FOV: 45 degrees; CFP; image size 1960x1897 — 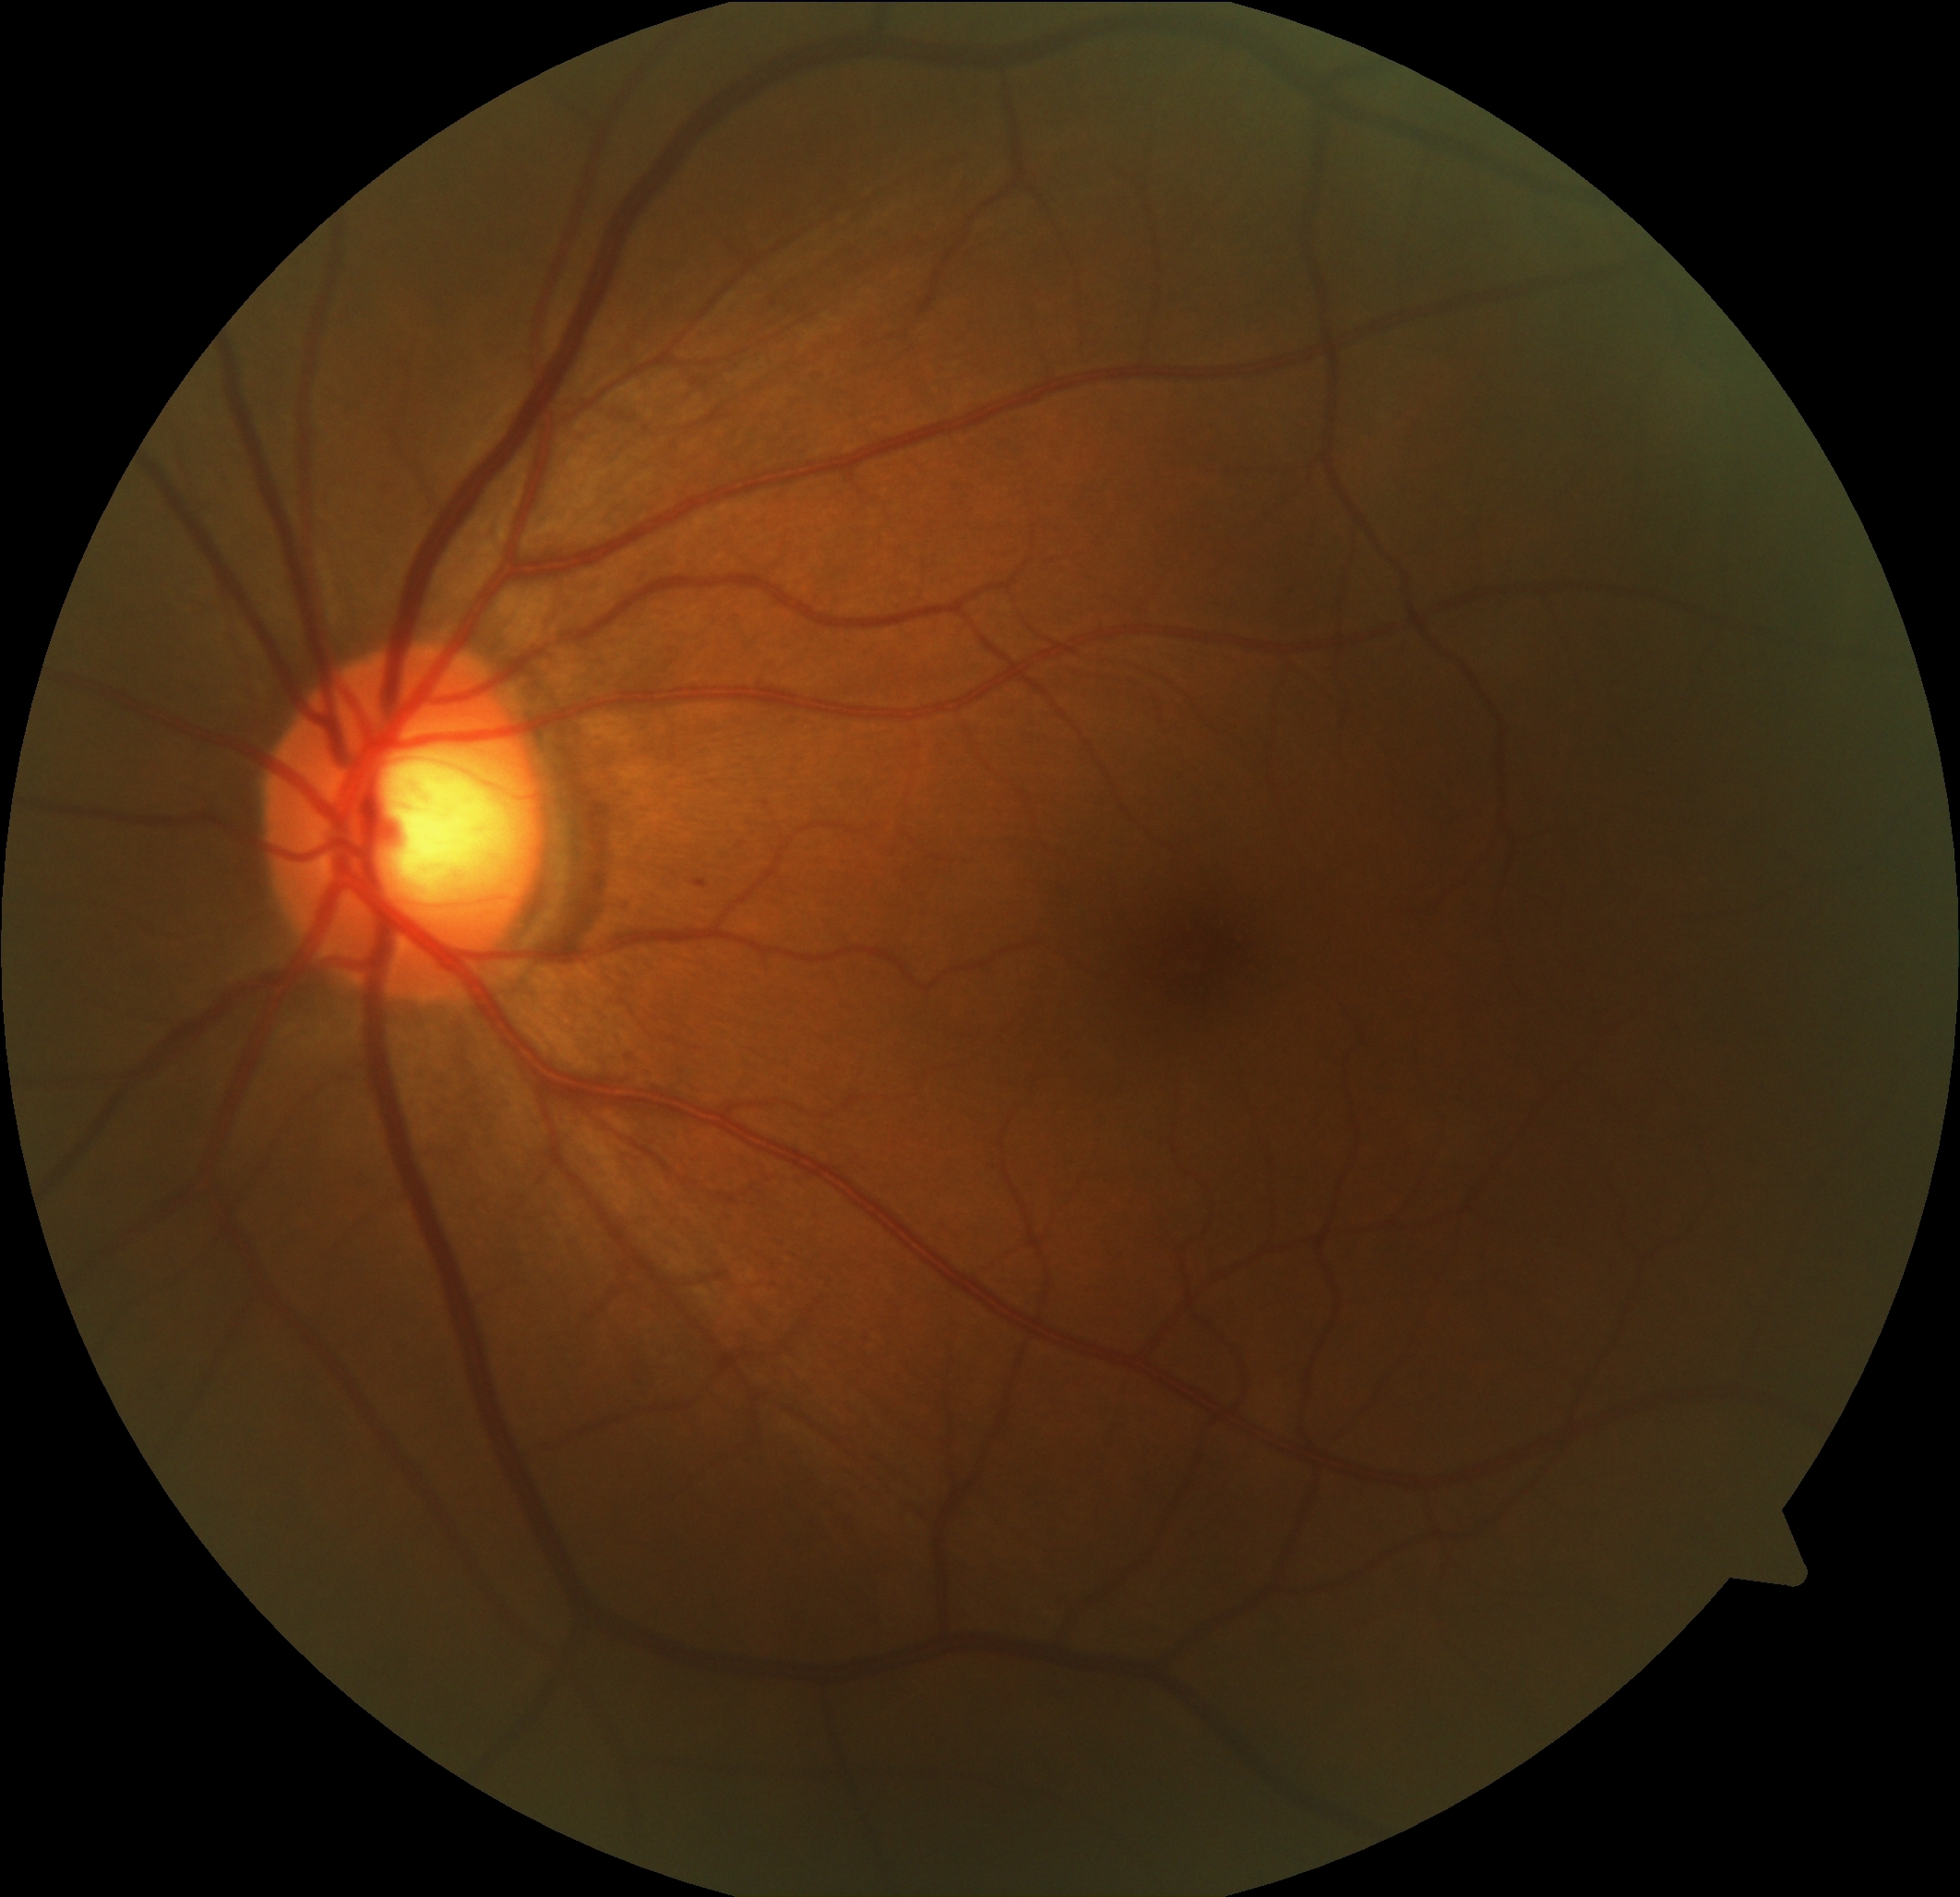 • DR — grade 1 (mild NPDR)